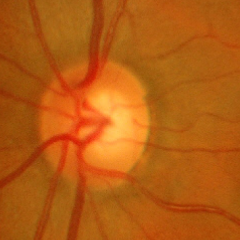 No glaucomatous optic neuropathy.